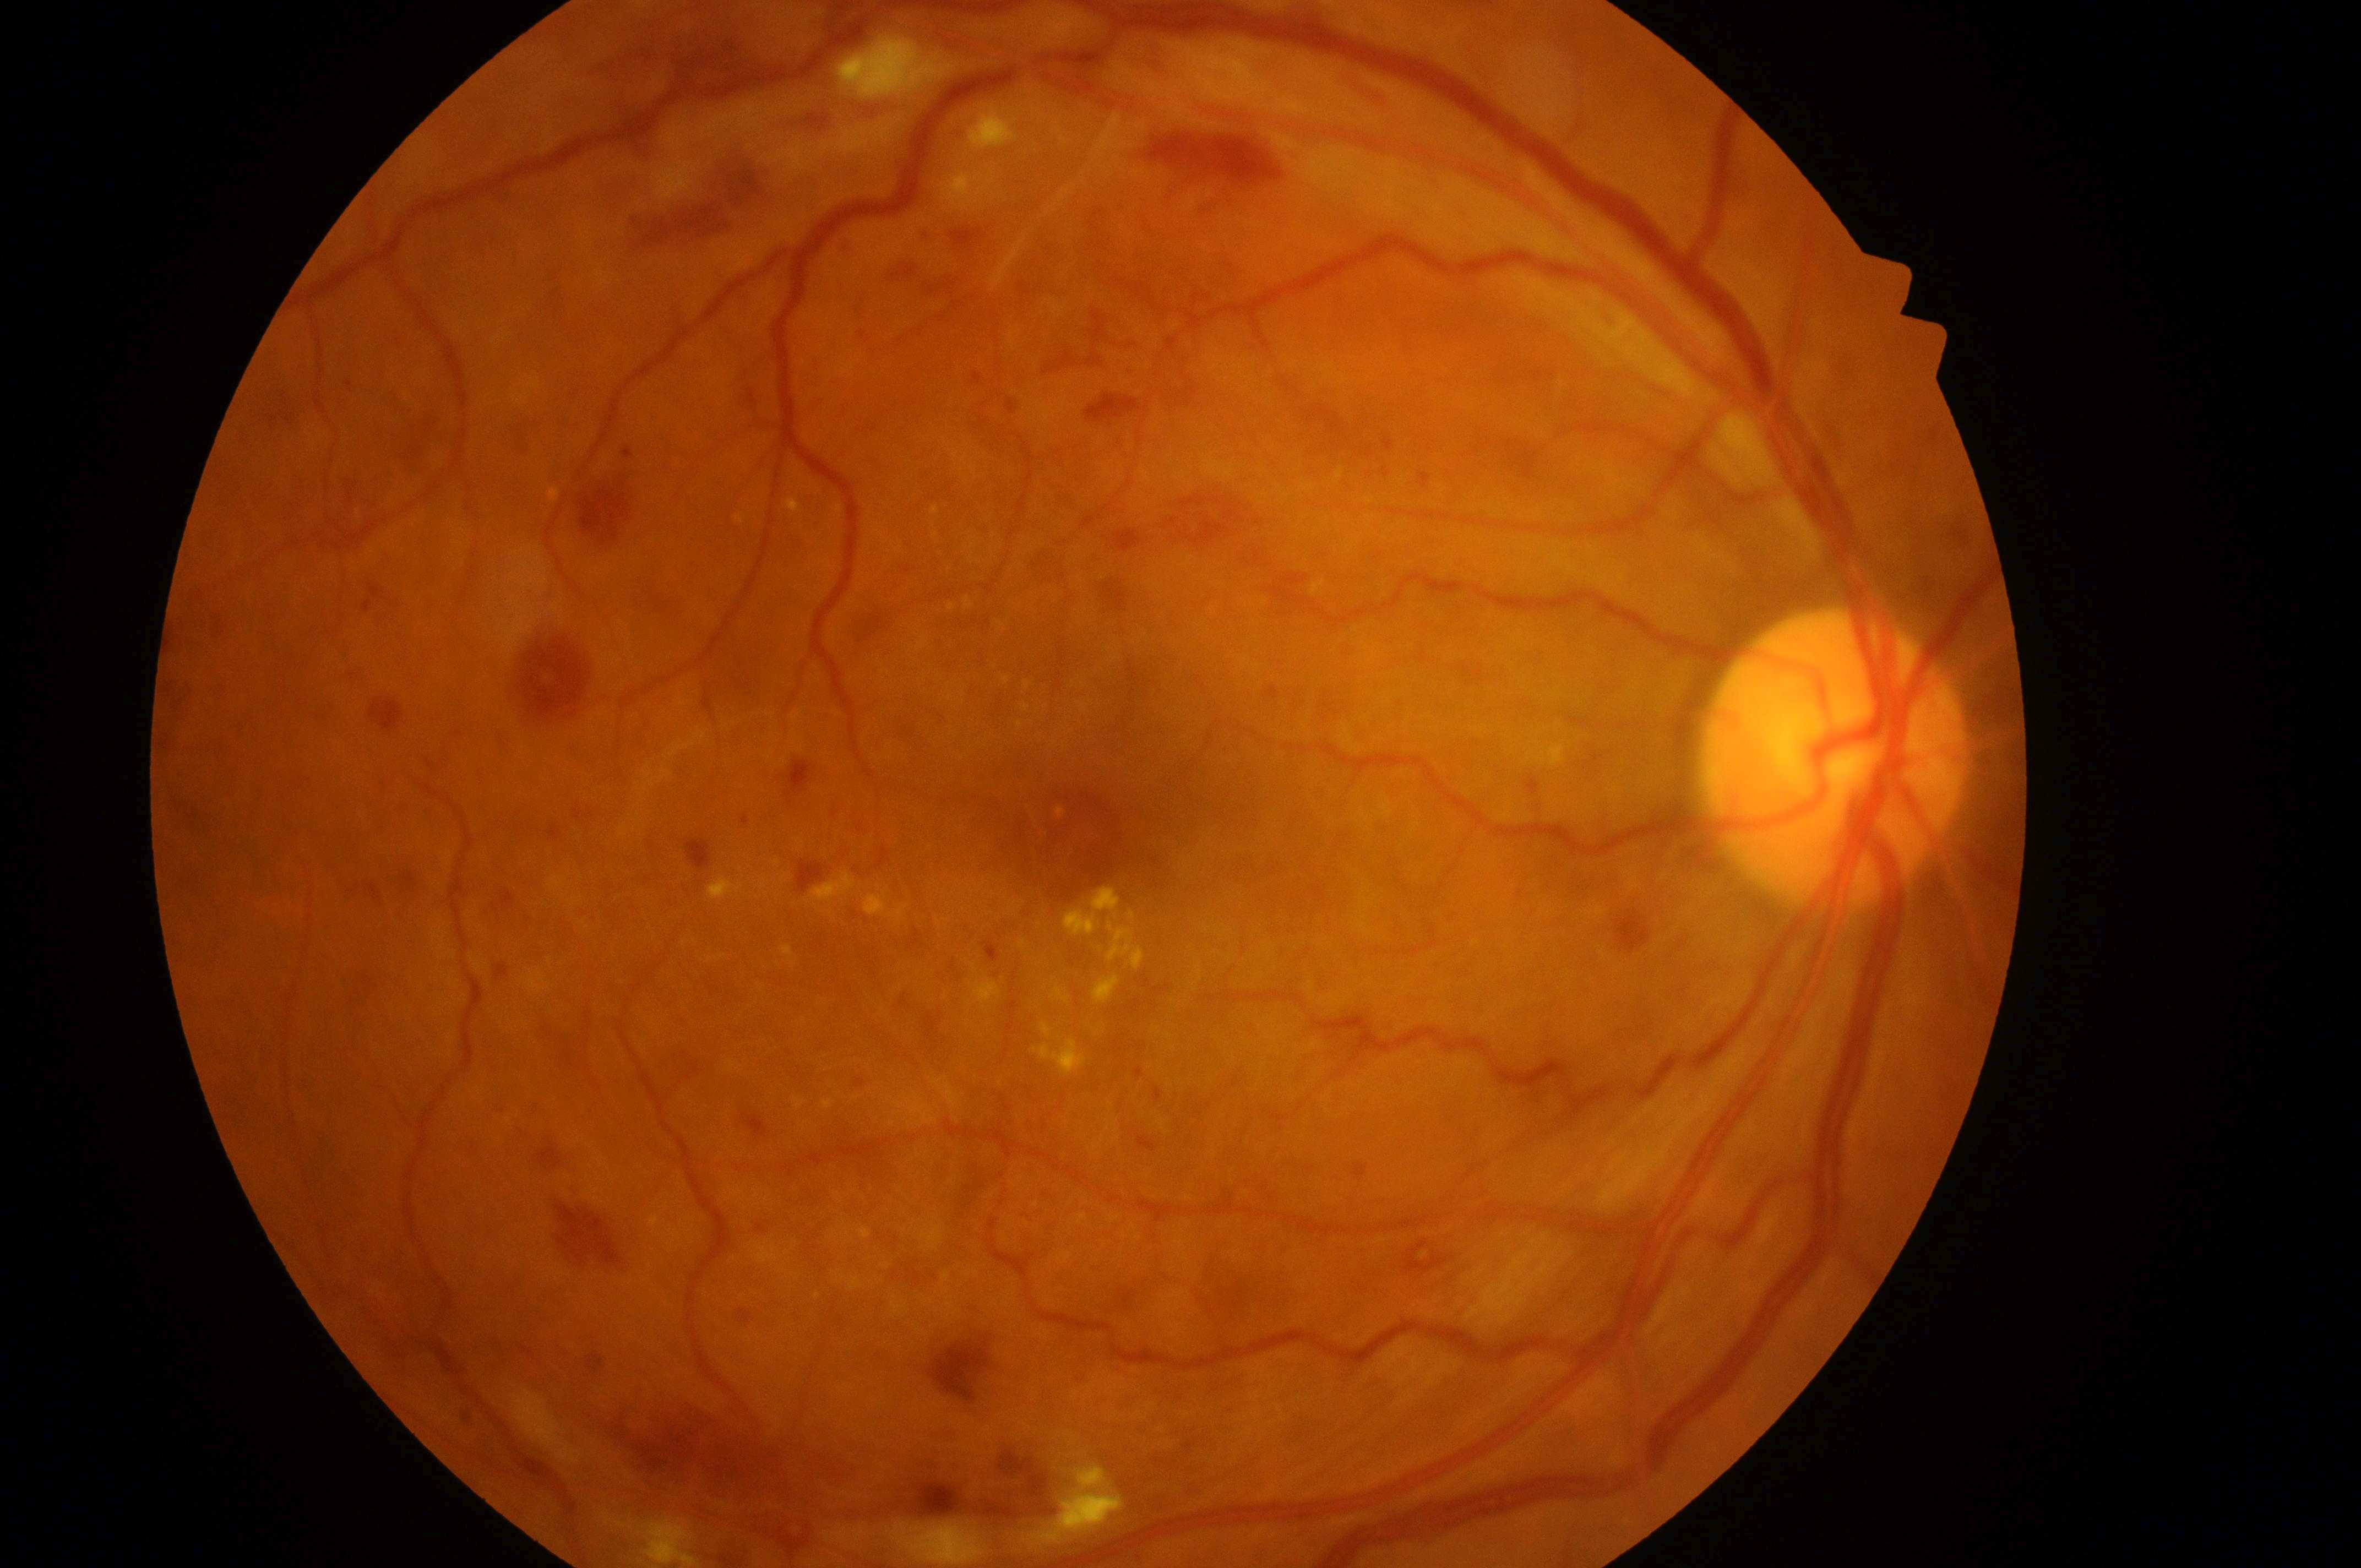
Diabetic retinopathy (DR) is grade 4 (PDR).
The optic disc center is at (1836, 771).
Diabetic macular edema (DME): grade 2 (high risk).
The fovea center is at (1116, 793).
Imaged eye: OD.